Diabetic retinopathy graded by the modified Davis classification; NIDEK AFC-230
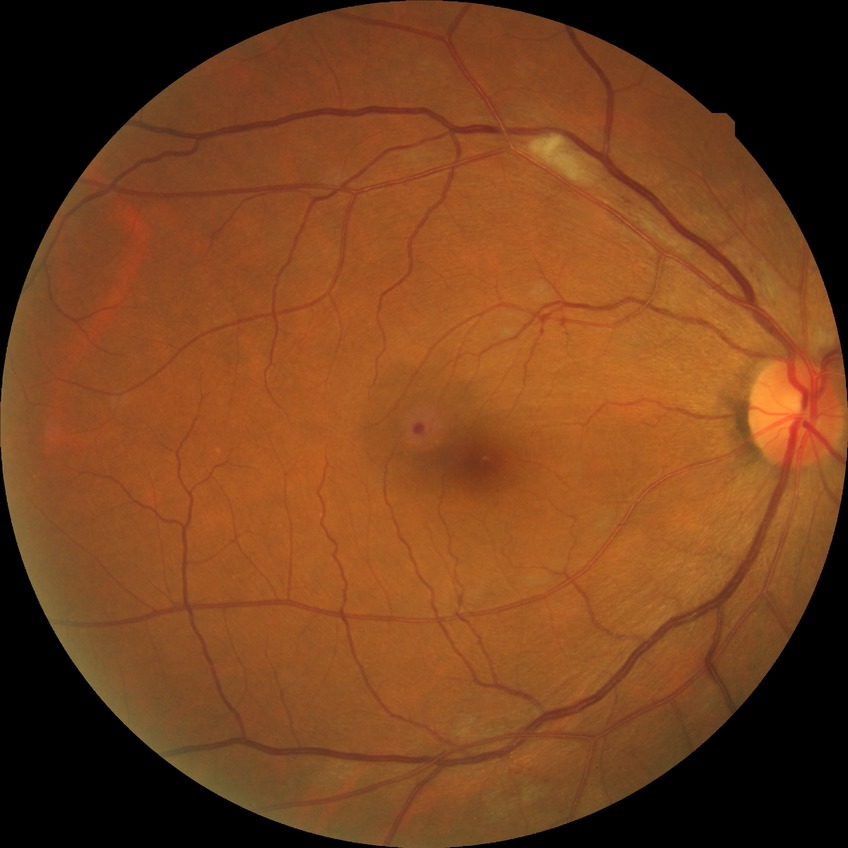 diabetic retinopathy (DR)=pre-proliferative diabetic retinopathy (PPDR).